Graded on the modified Davis scale — 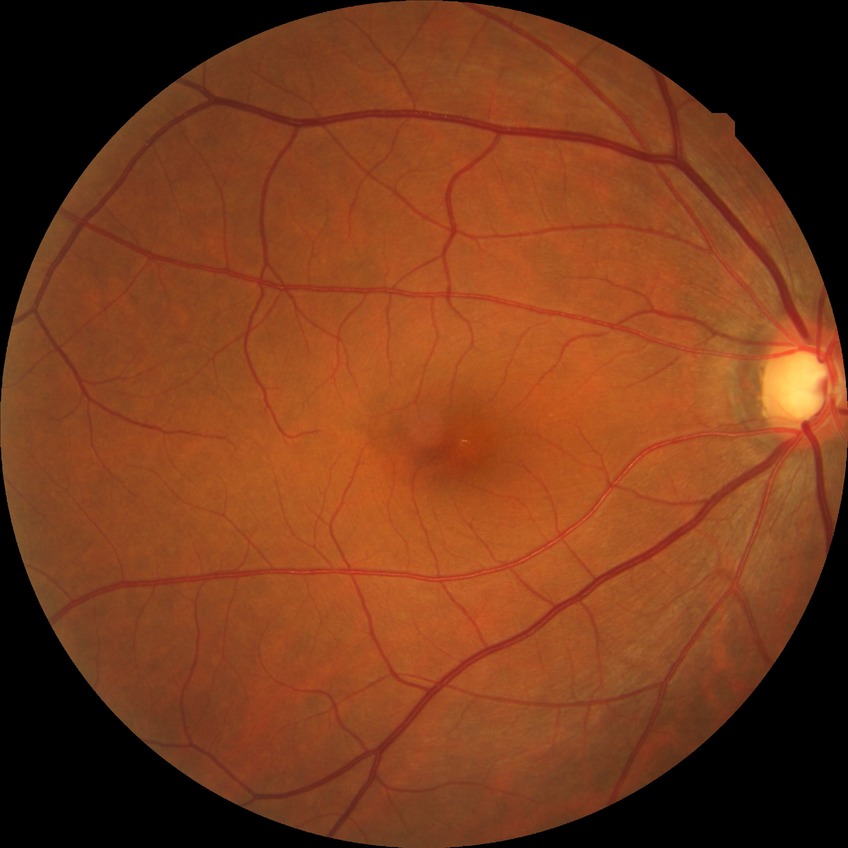 No signs of diabetic retinopathy. DR stage is NDR.